45° field of view:
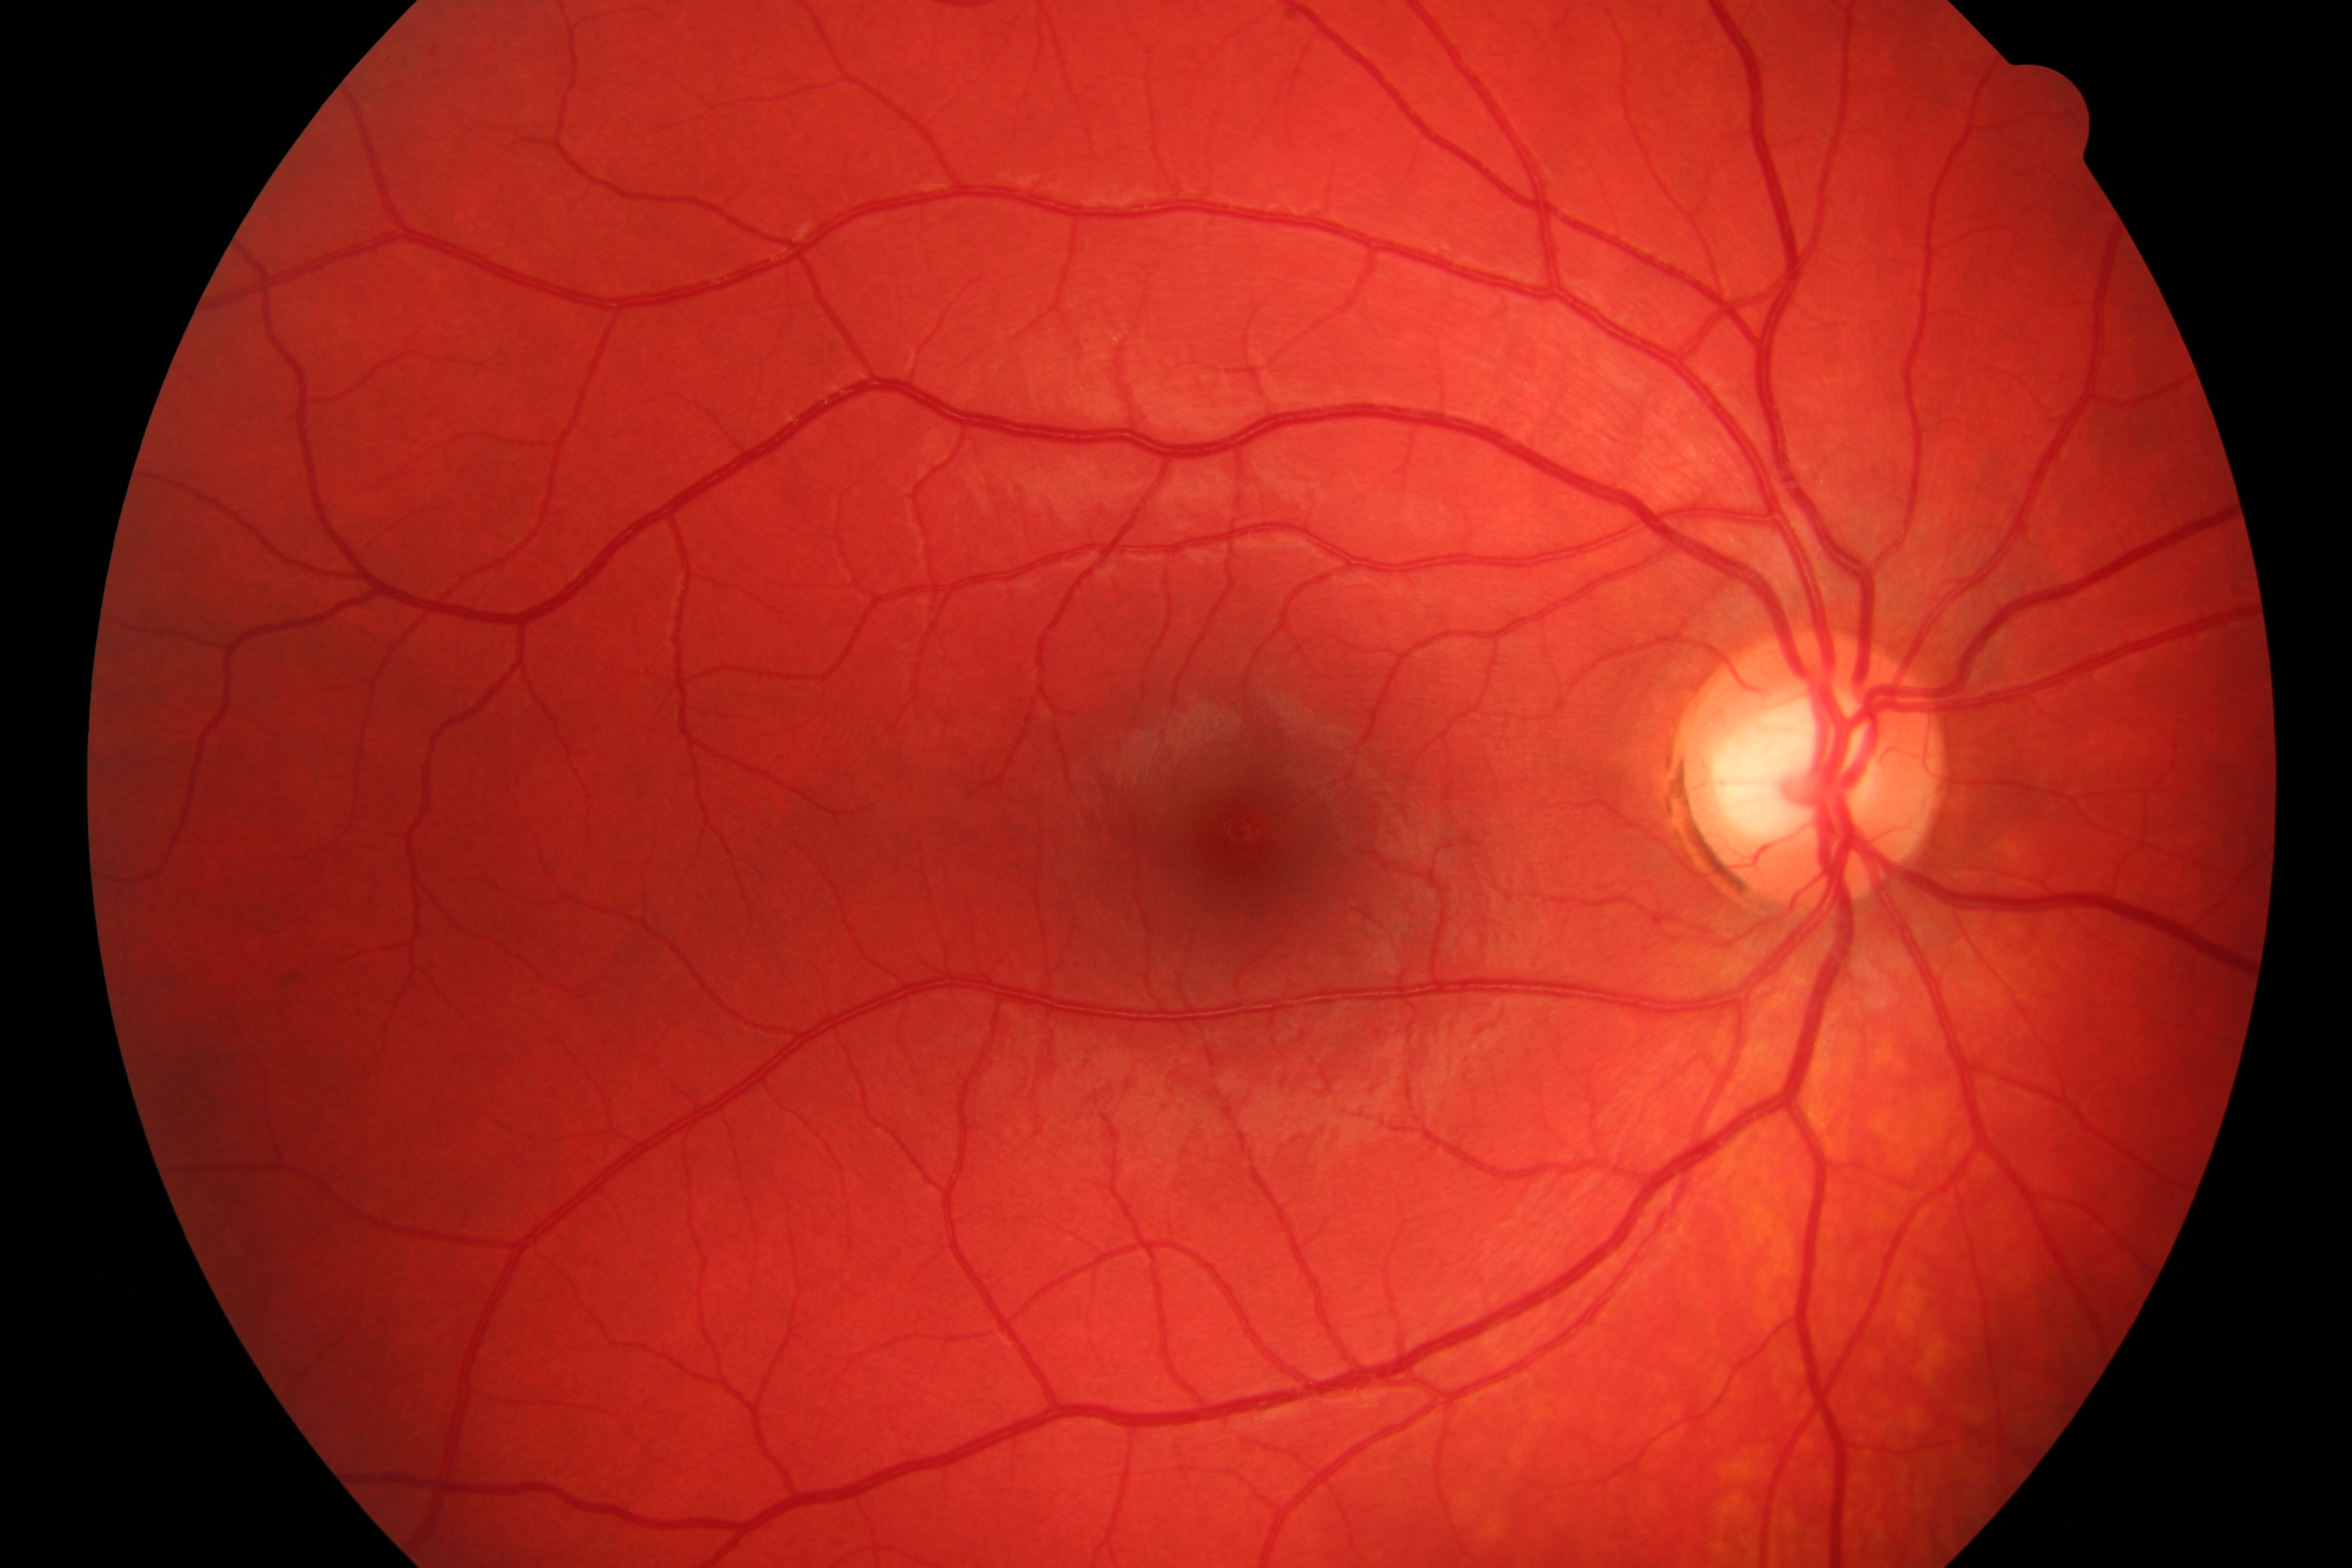 Fundus photograph showing no diabetic retinopathy or glaucomatous findings.